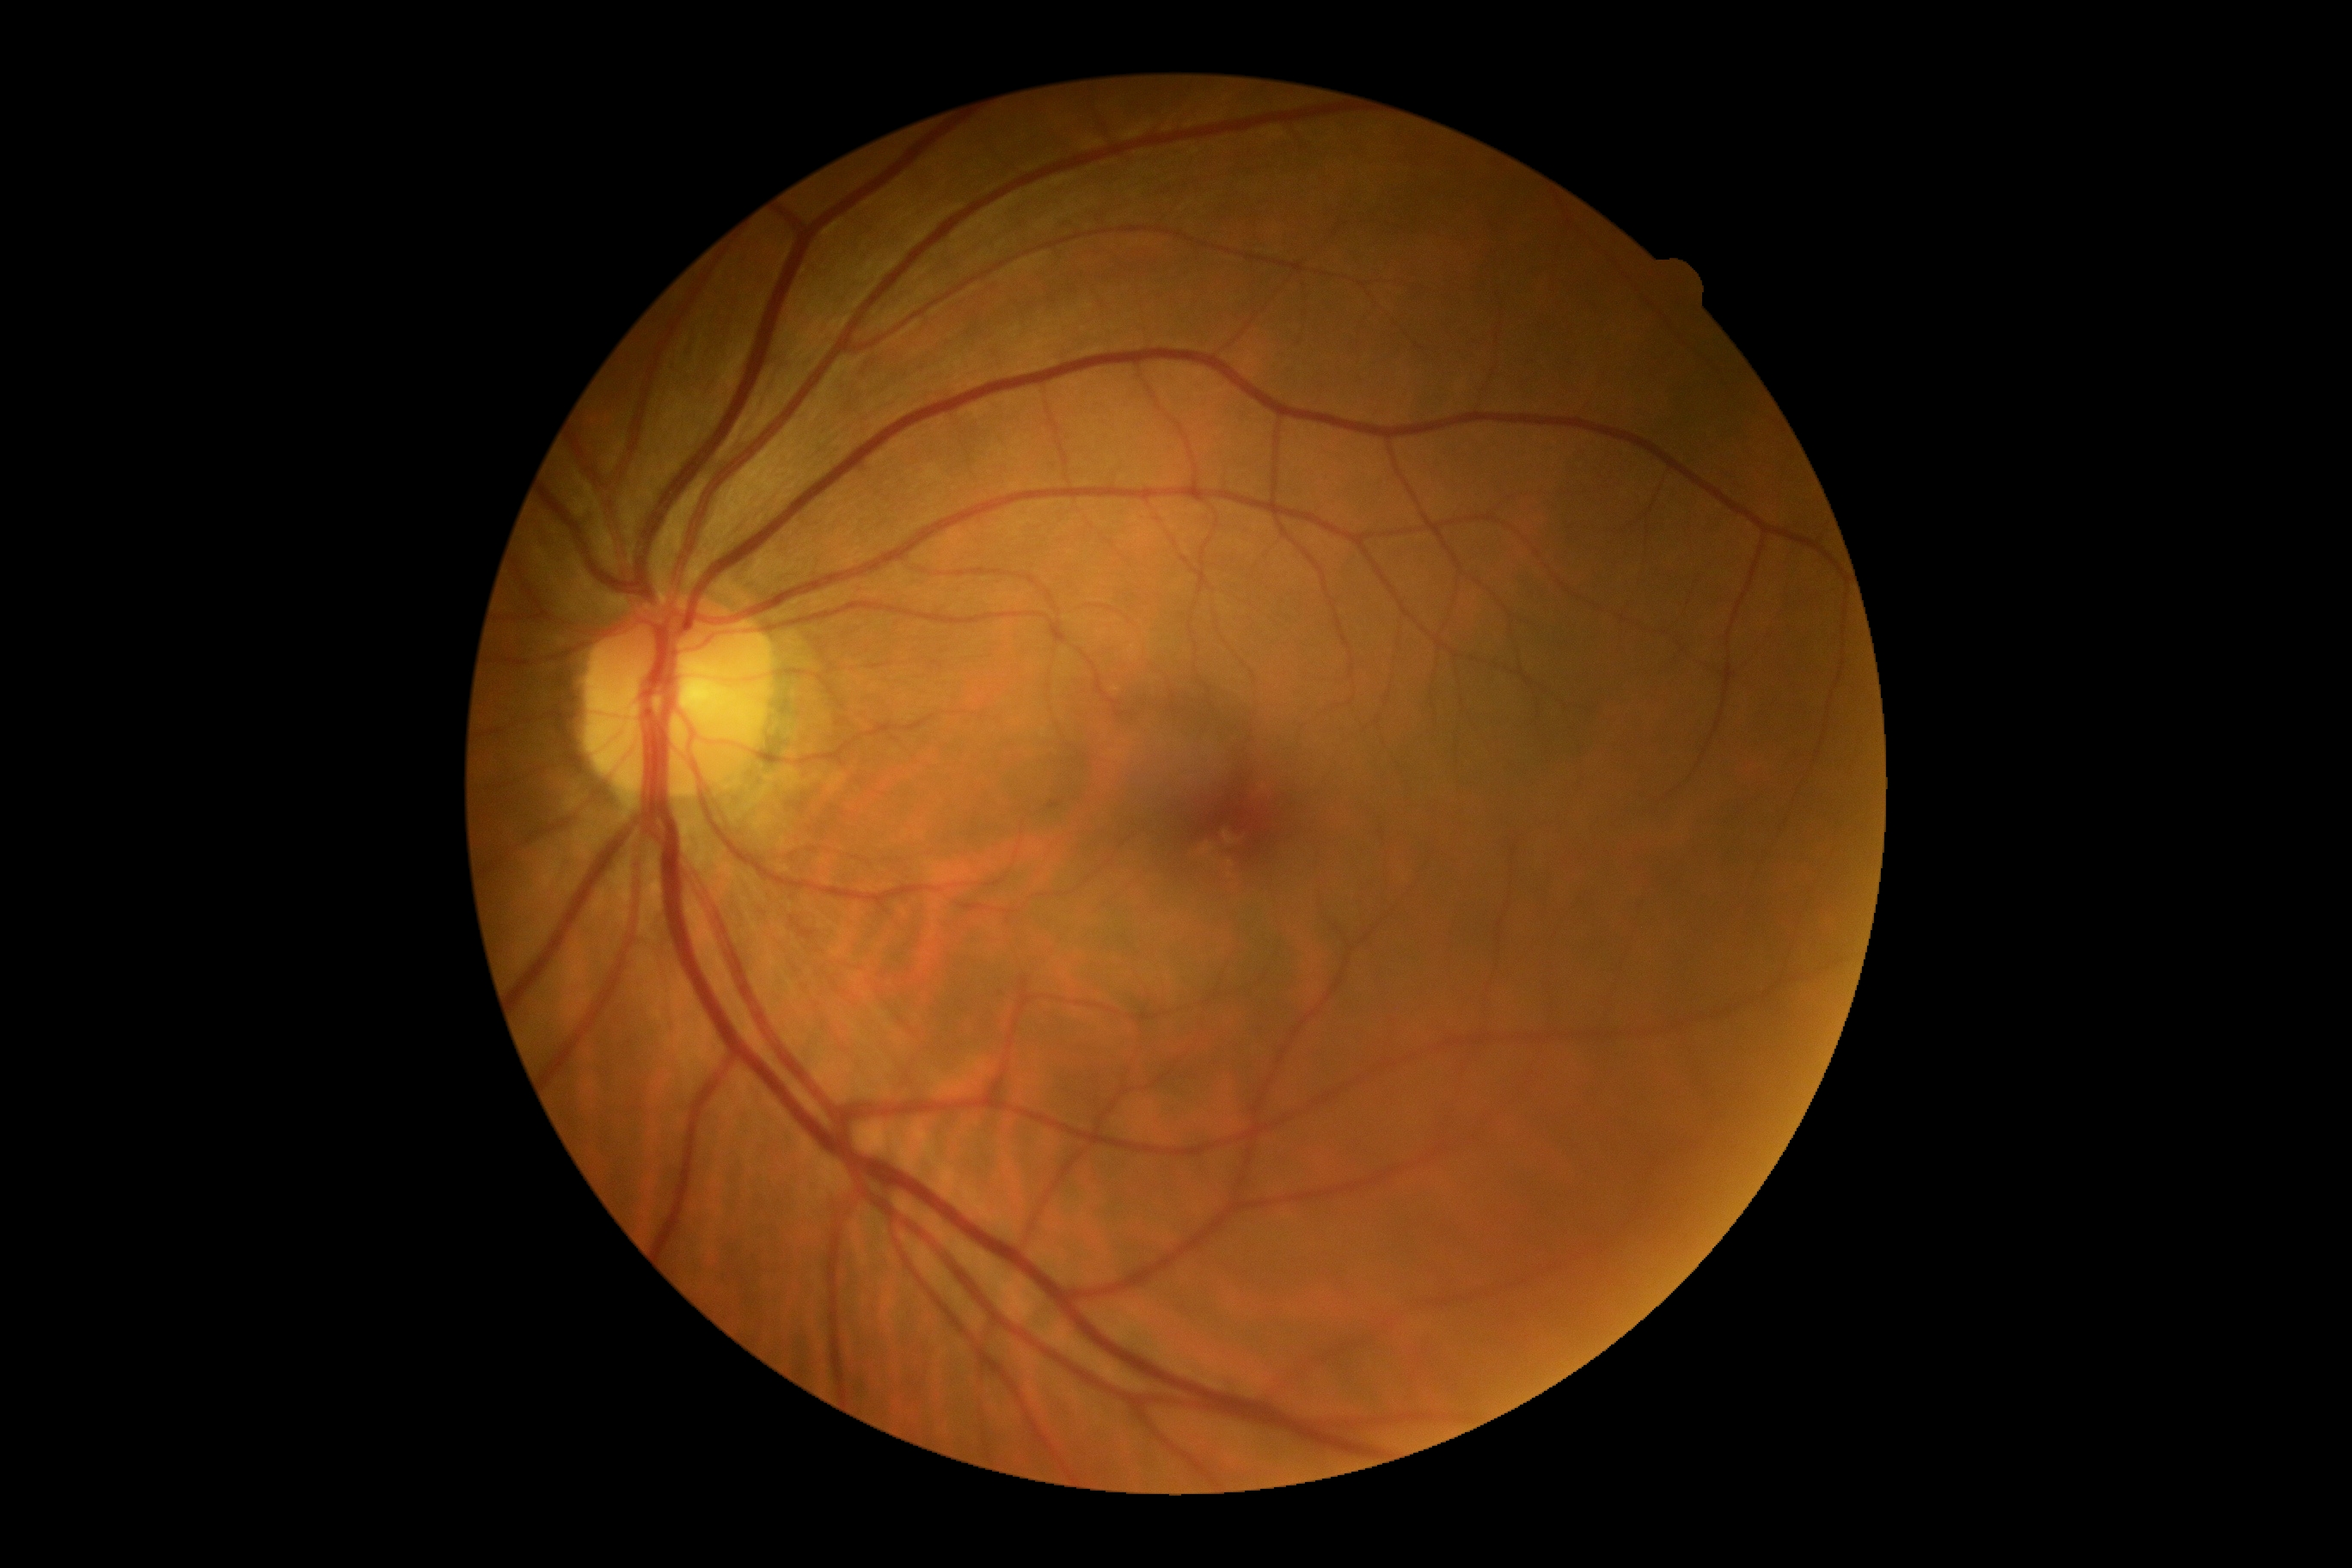

retinopathy grade: no apparent retinopathy (0).